Nonmydriatic: 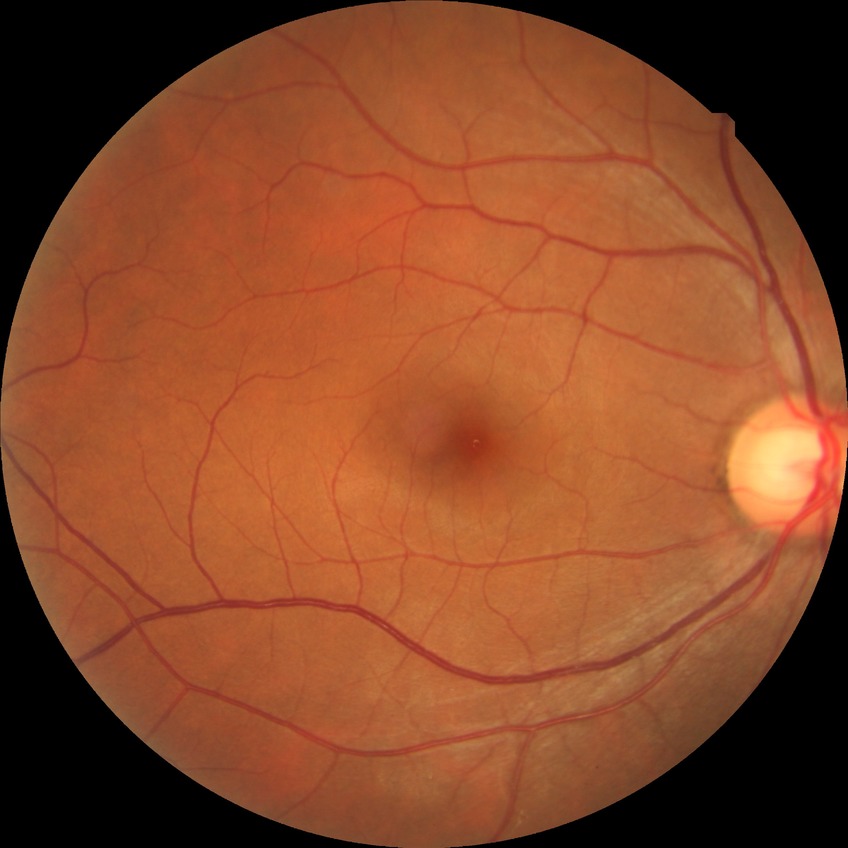

Retinopathy stage is no diabetic retinopathy.